45-degree field of view:
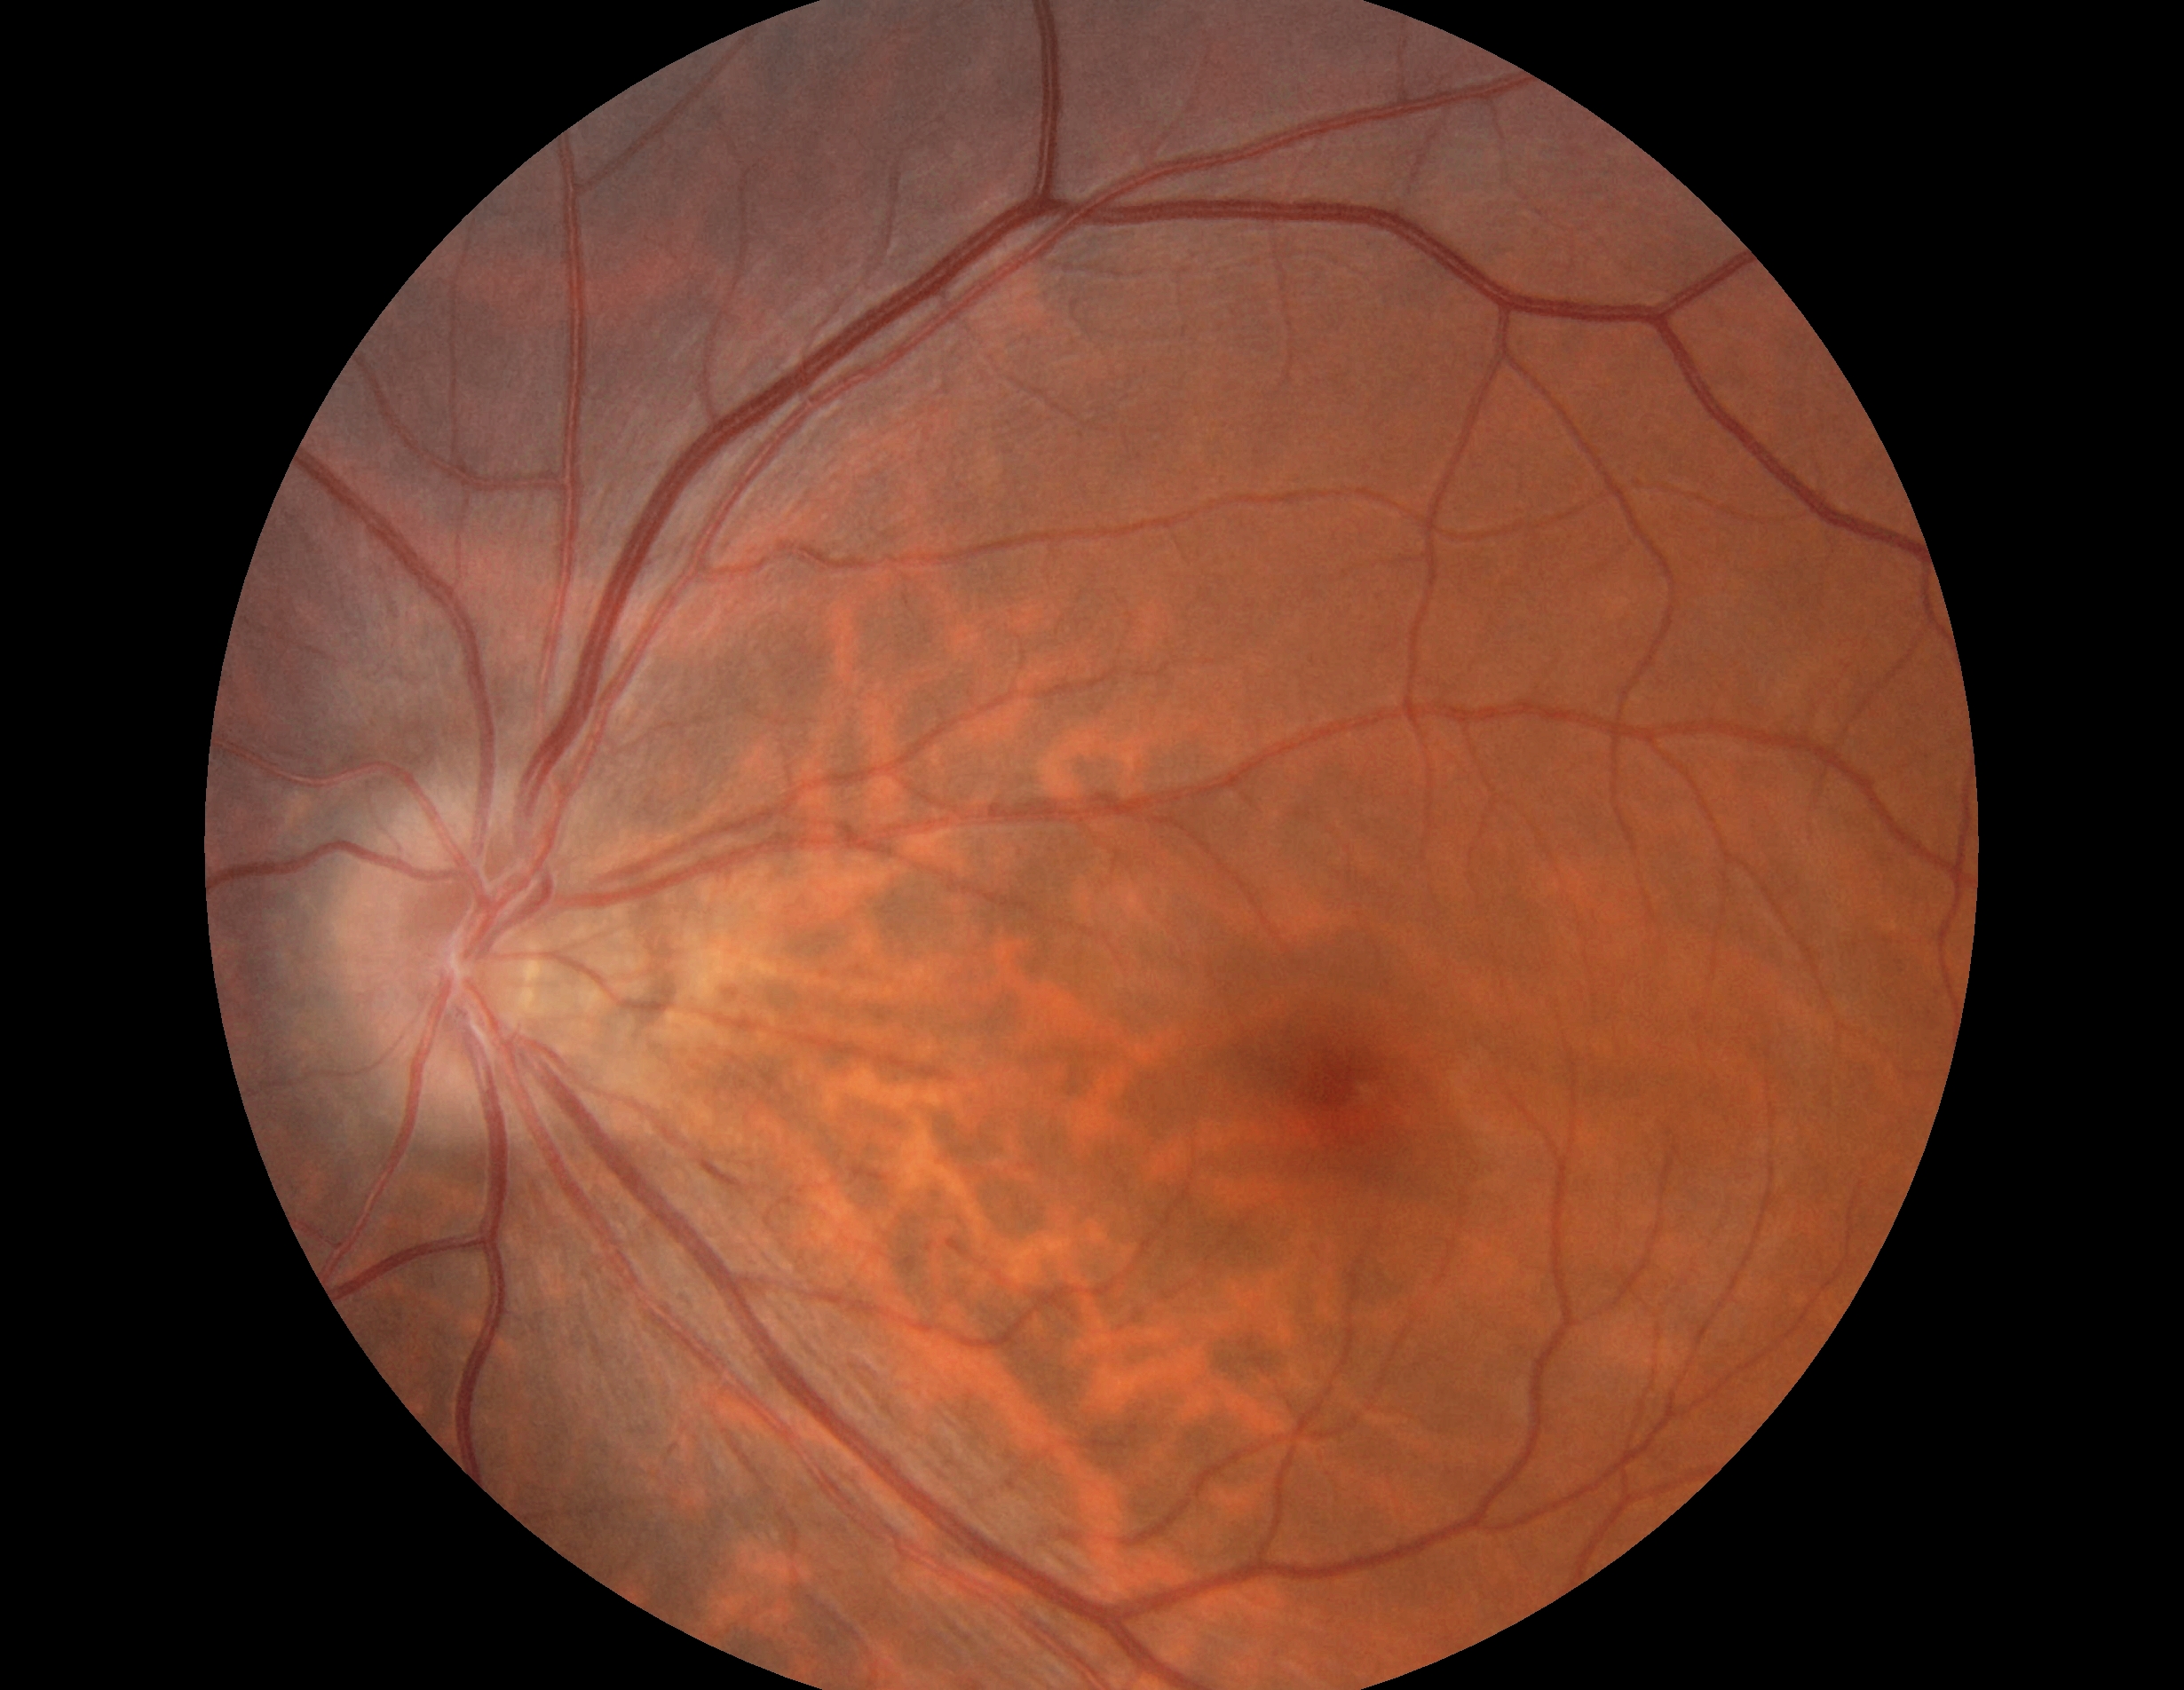 DR grade: 0 (no apparent retinopathy).